NIDEK AFC-230; modified Davis classification.
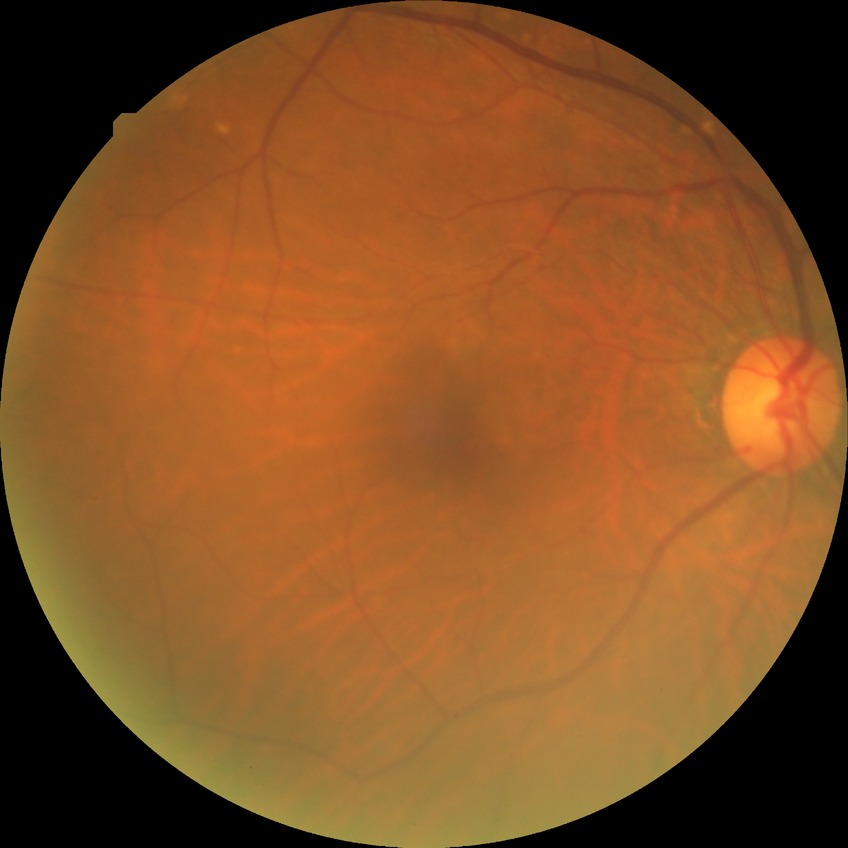 Diabetic retinopathy (DR): NDR (no diabetic retinopathy).